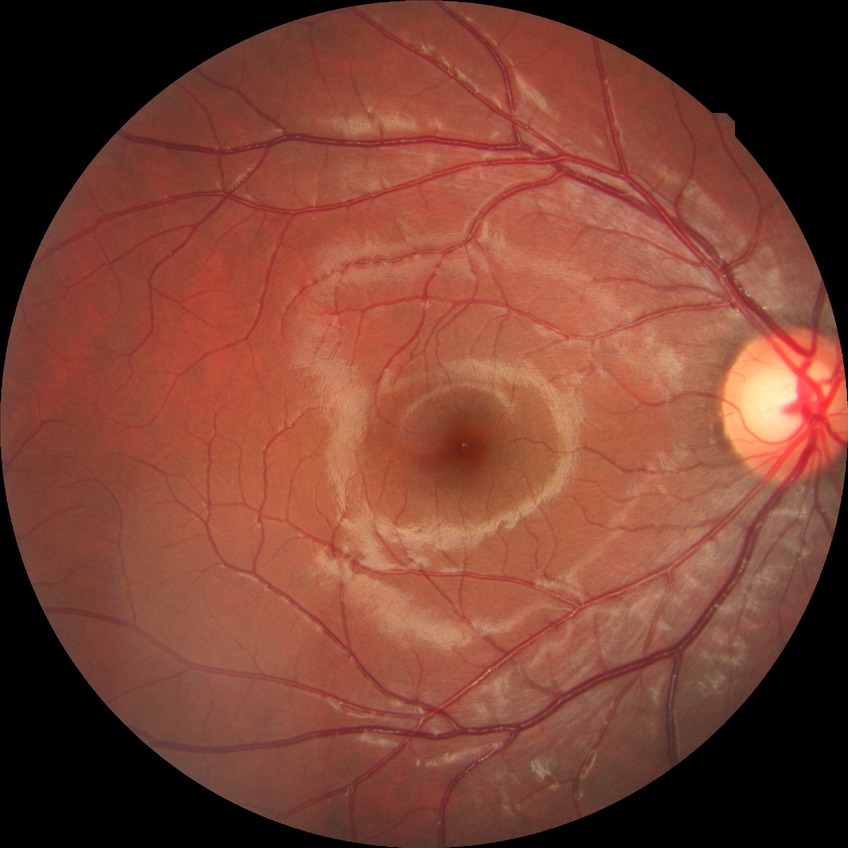
  davis_grade: no diabetic retinopathy (NDR)